Retinal fundus photograph · 45-degree field of view · image size 2352x1568: 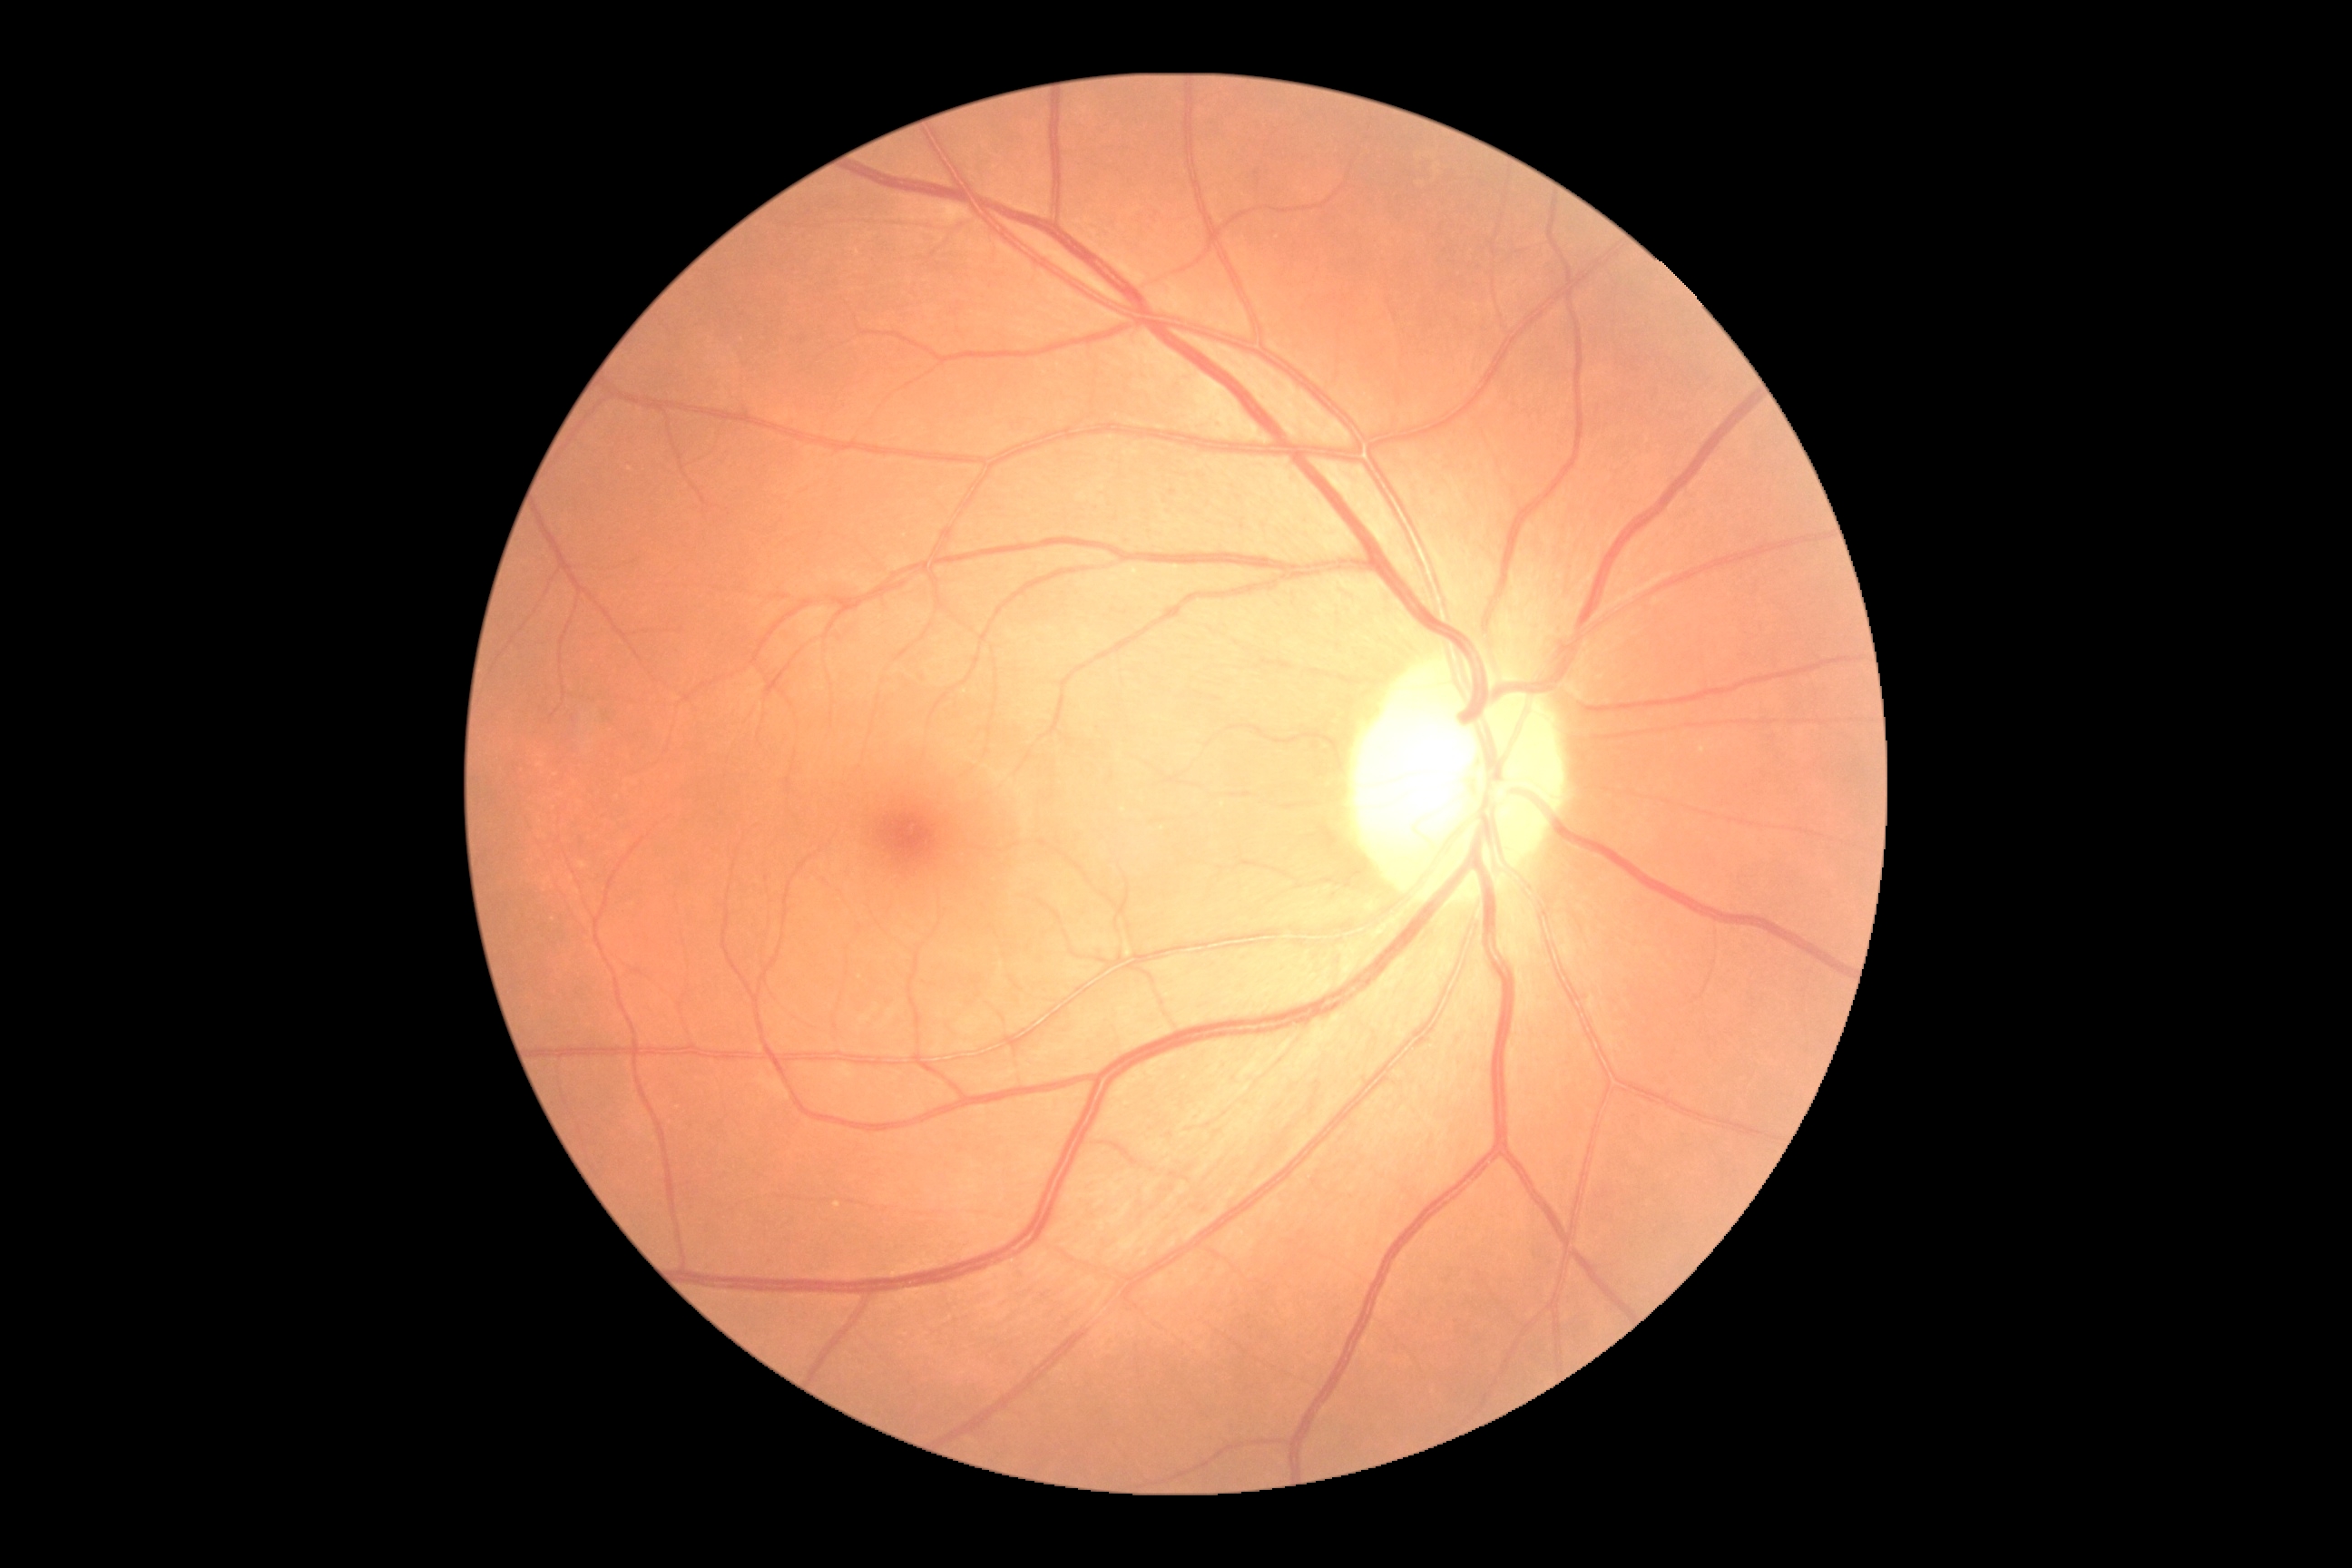 No diabetic retinal disease findings. DR grade: 0 (no apparent retinopathy) — no visible signs of diabetic retinopathy.